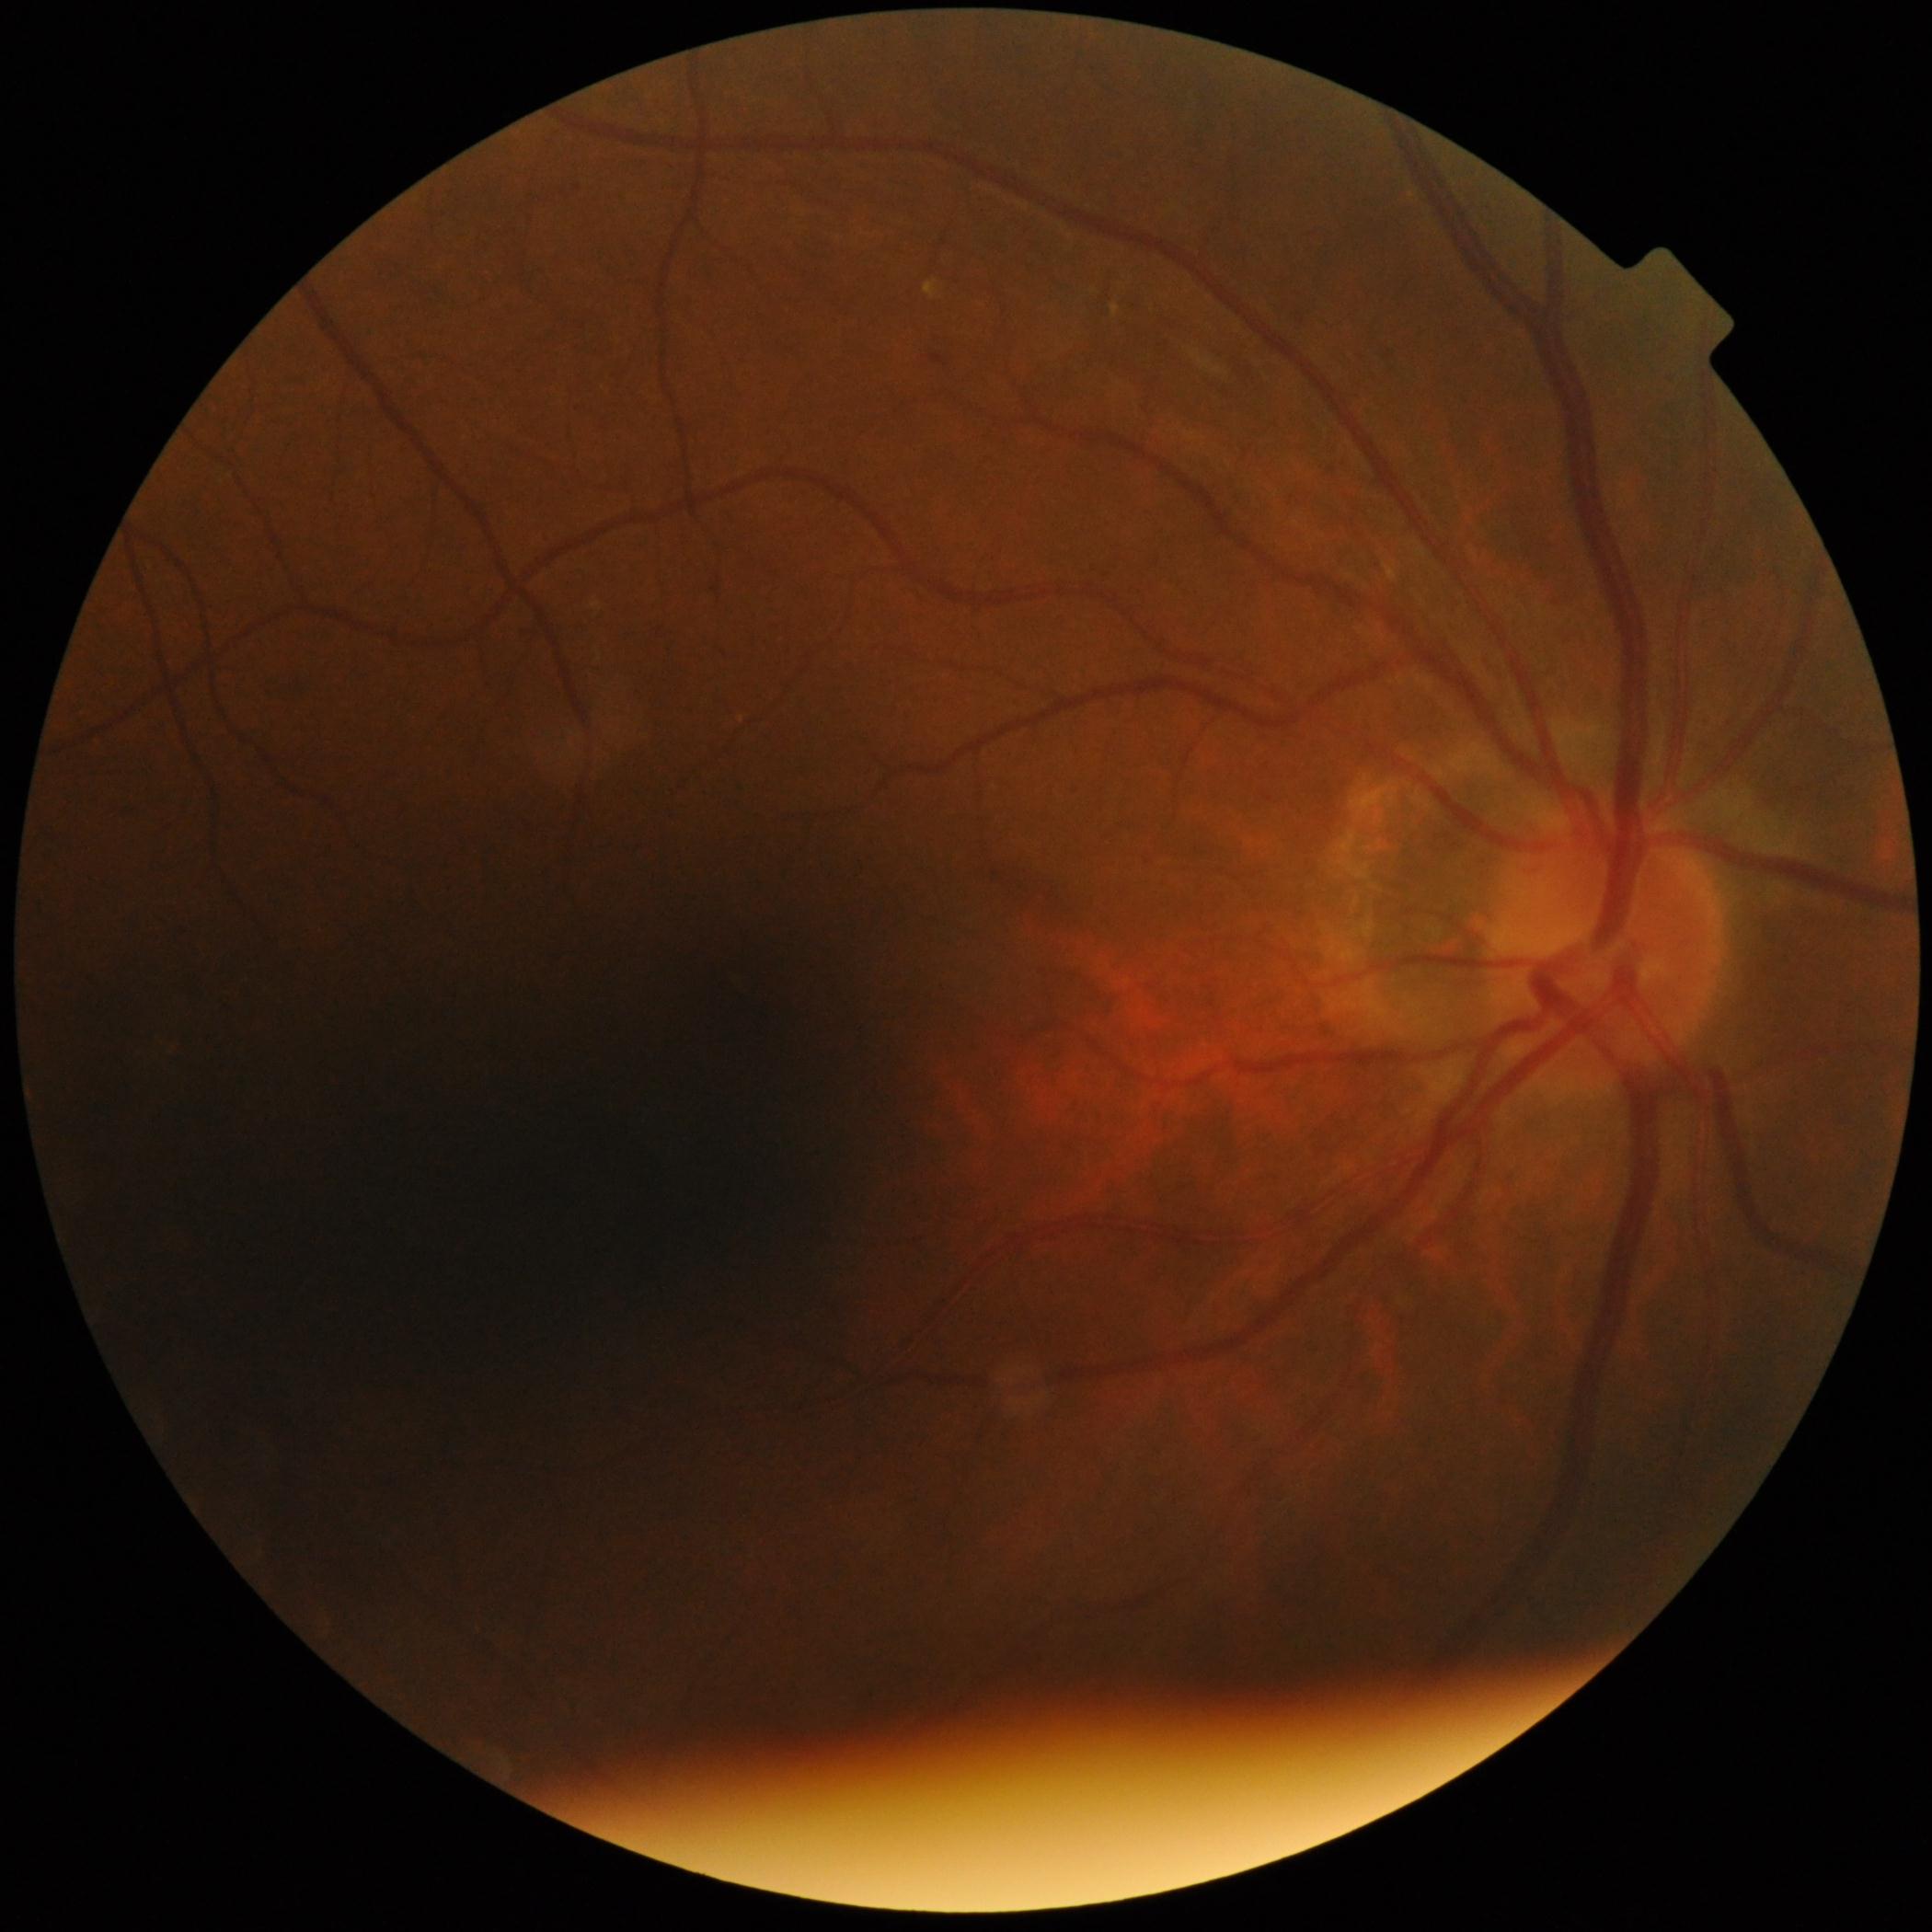 Retinopathy grade is moderate NPDR (2).